Macula-centered field; 2361x1568.
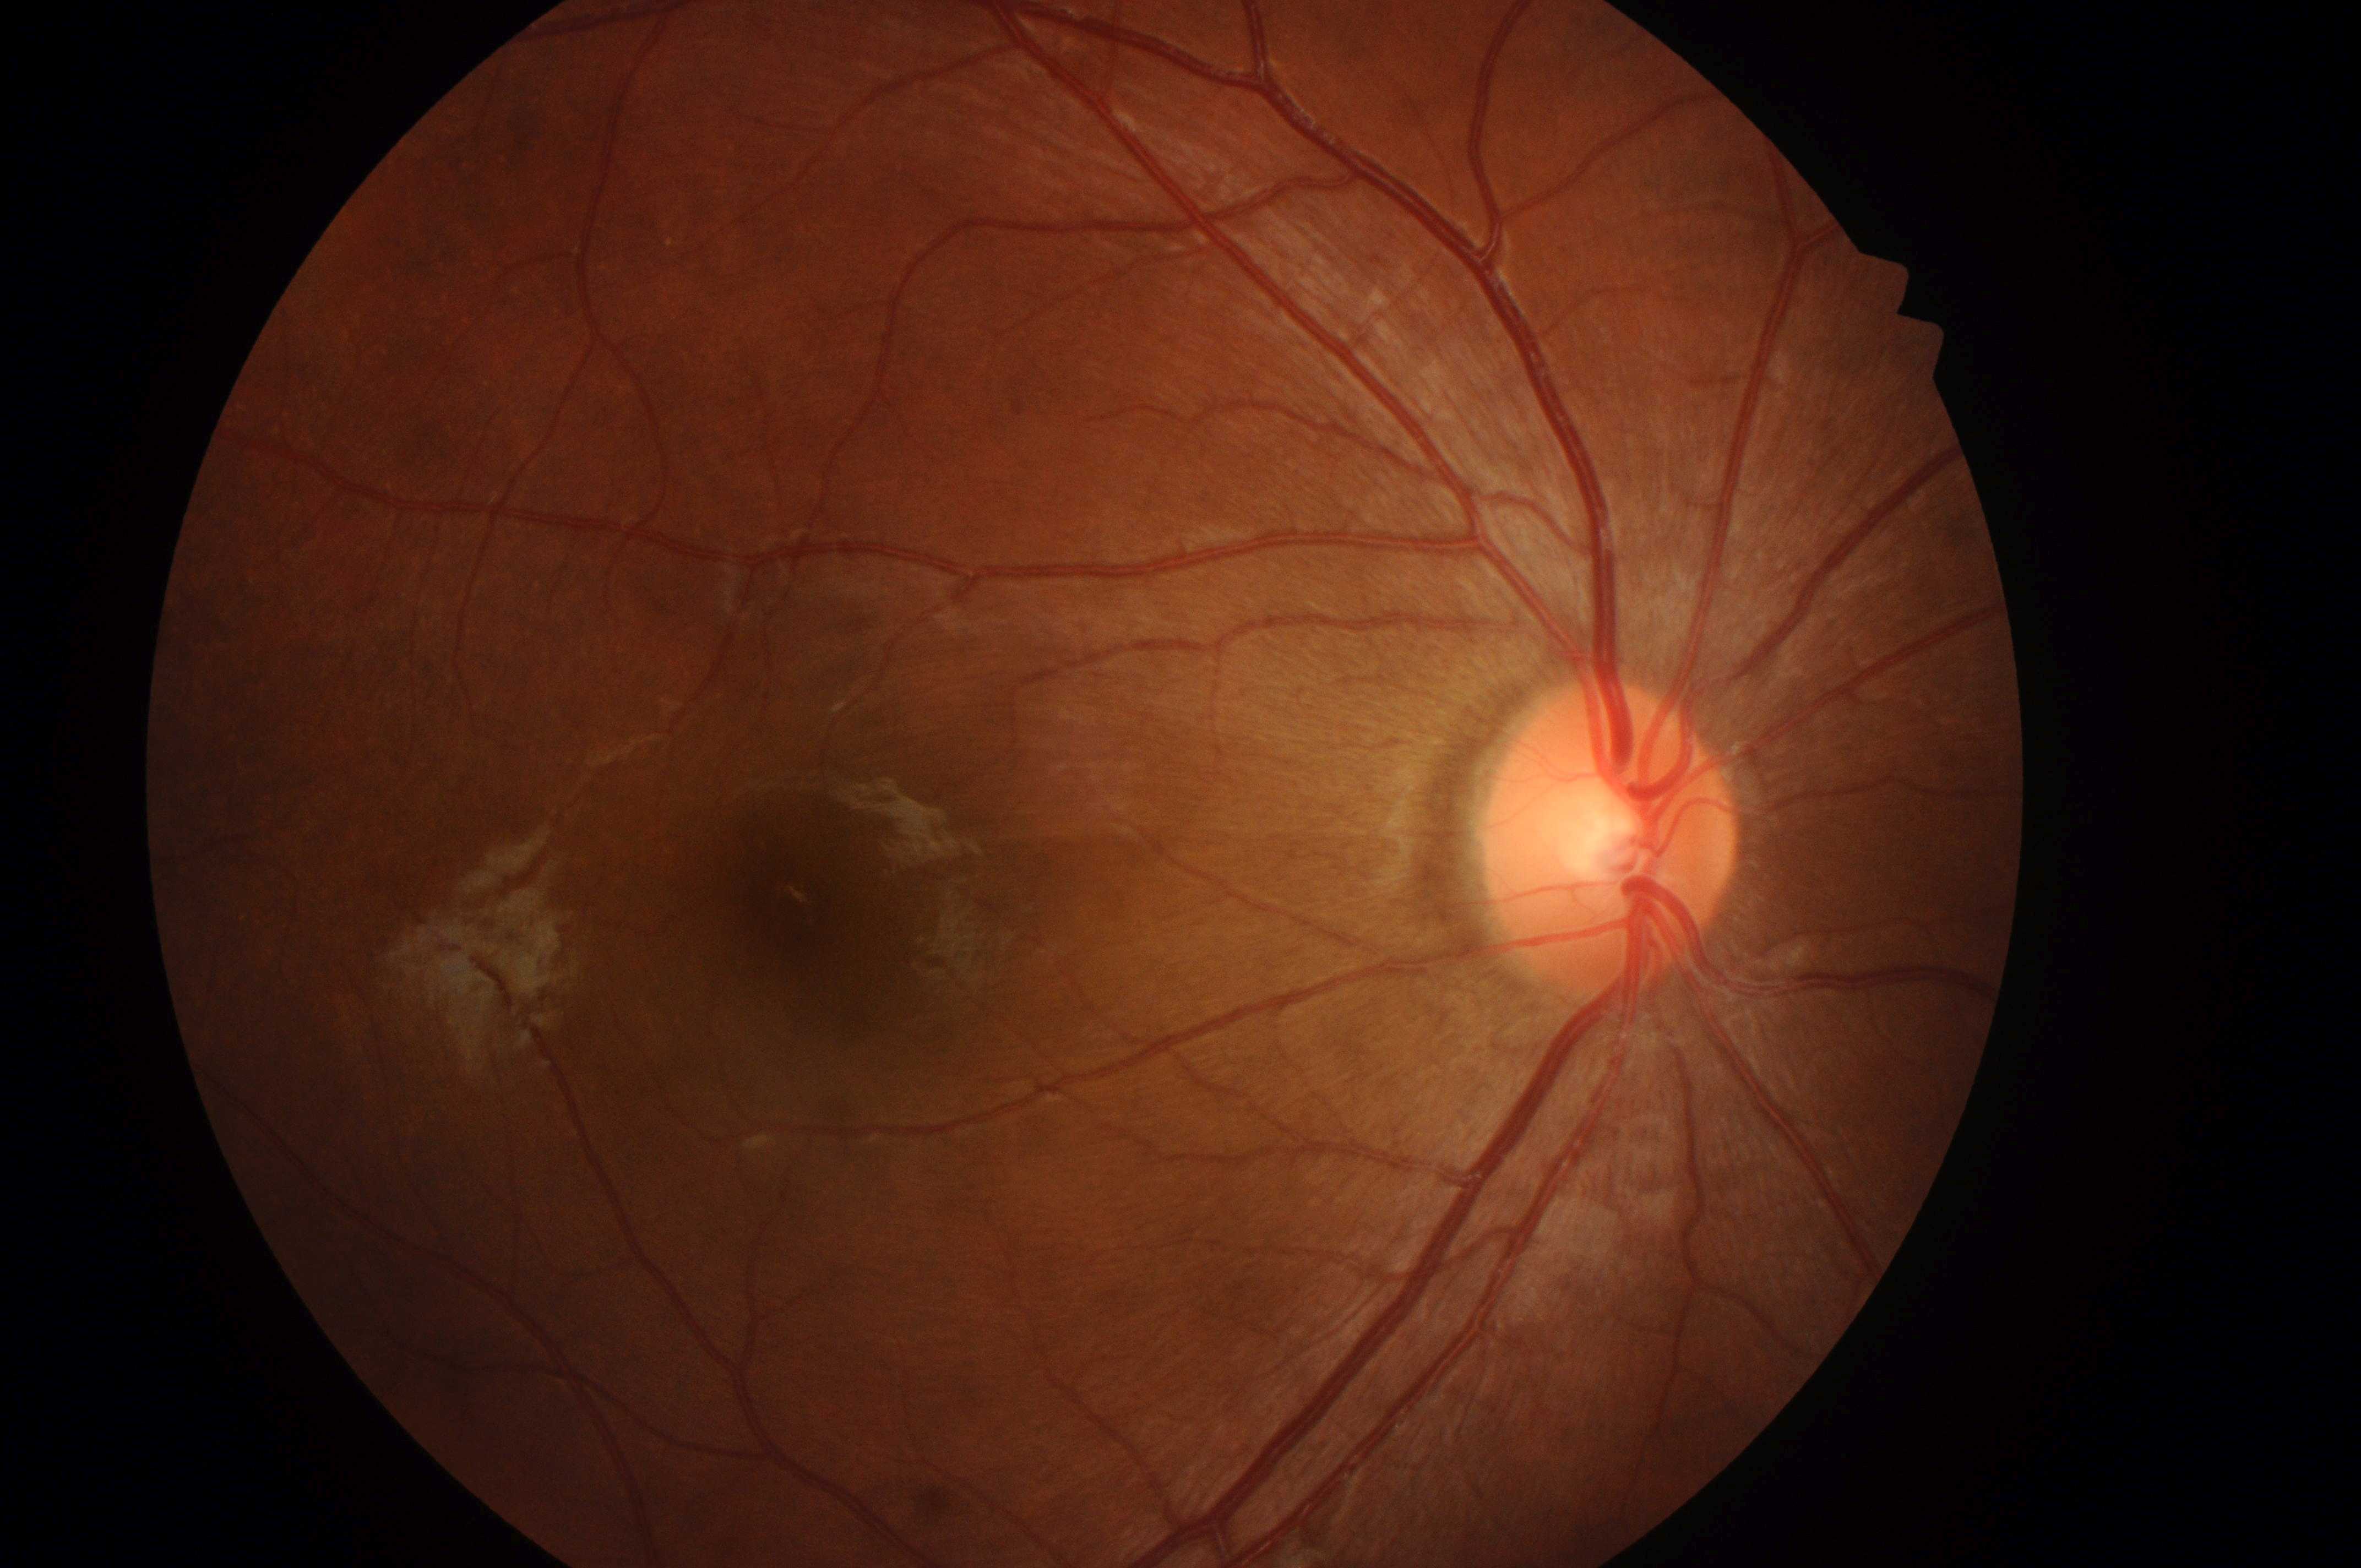

eye = OD | the fovea = (x: 790, y: 911) | retinopathy grade = 0 | risk of diabetic macular edema = 0/2 | DR impression = No DR or DME findings | optic disc = (x: 1607, y: 853).